2346x1568, 45° field of view: 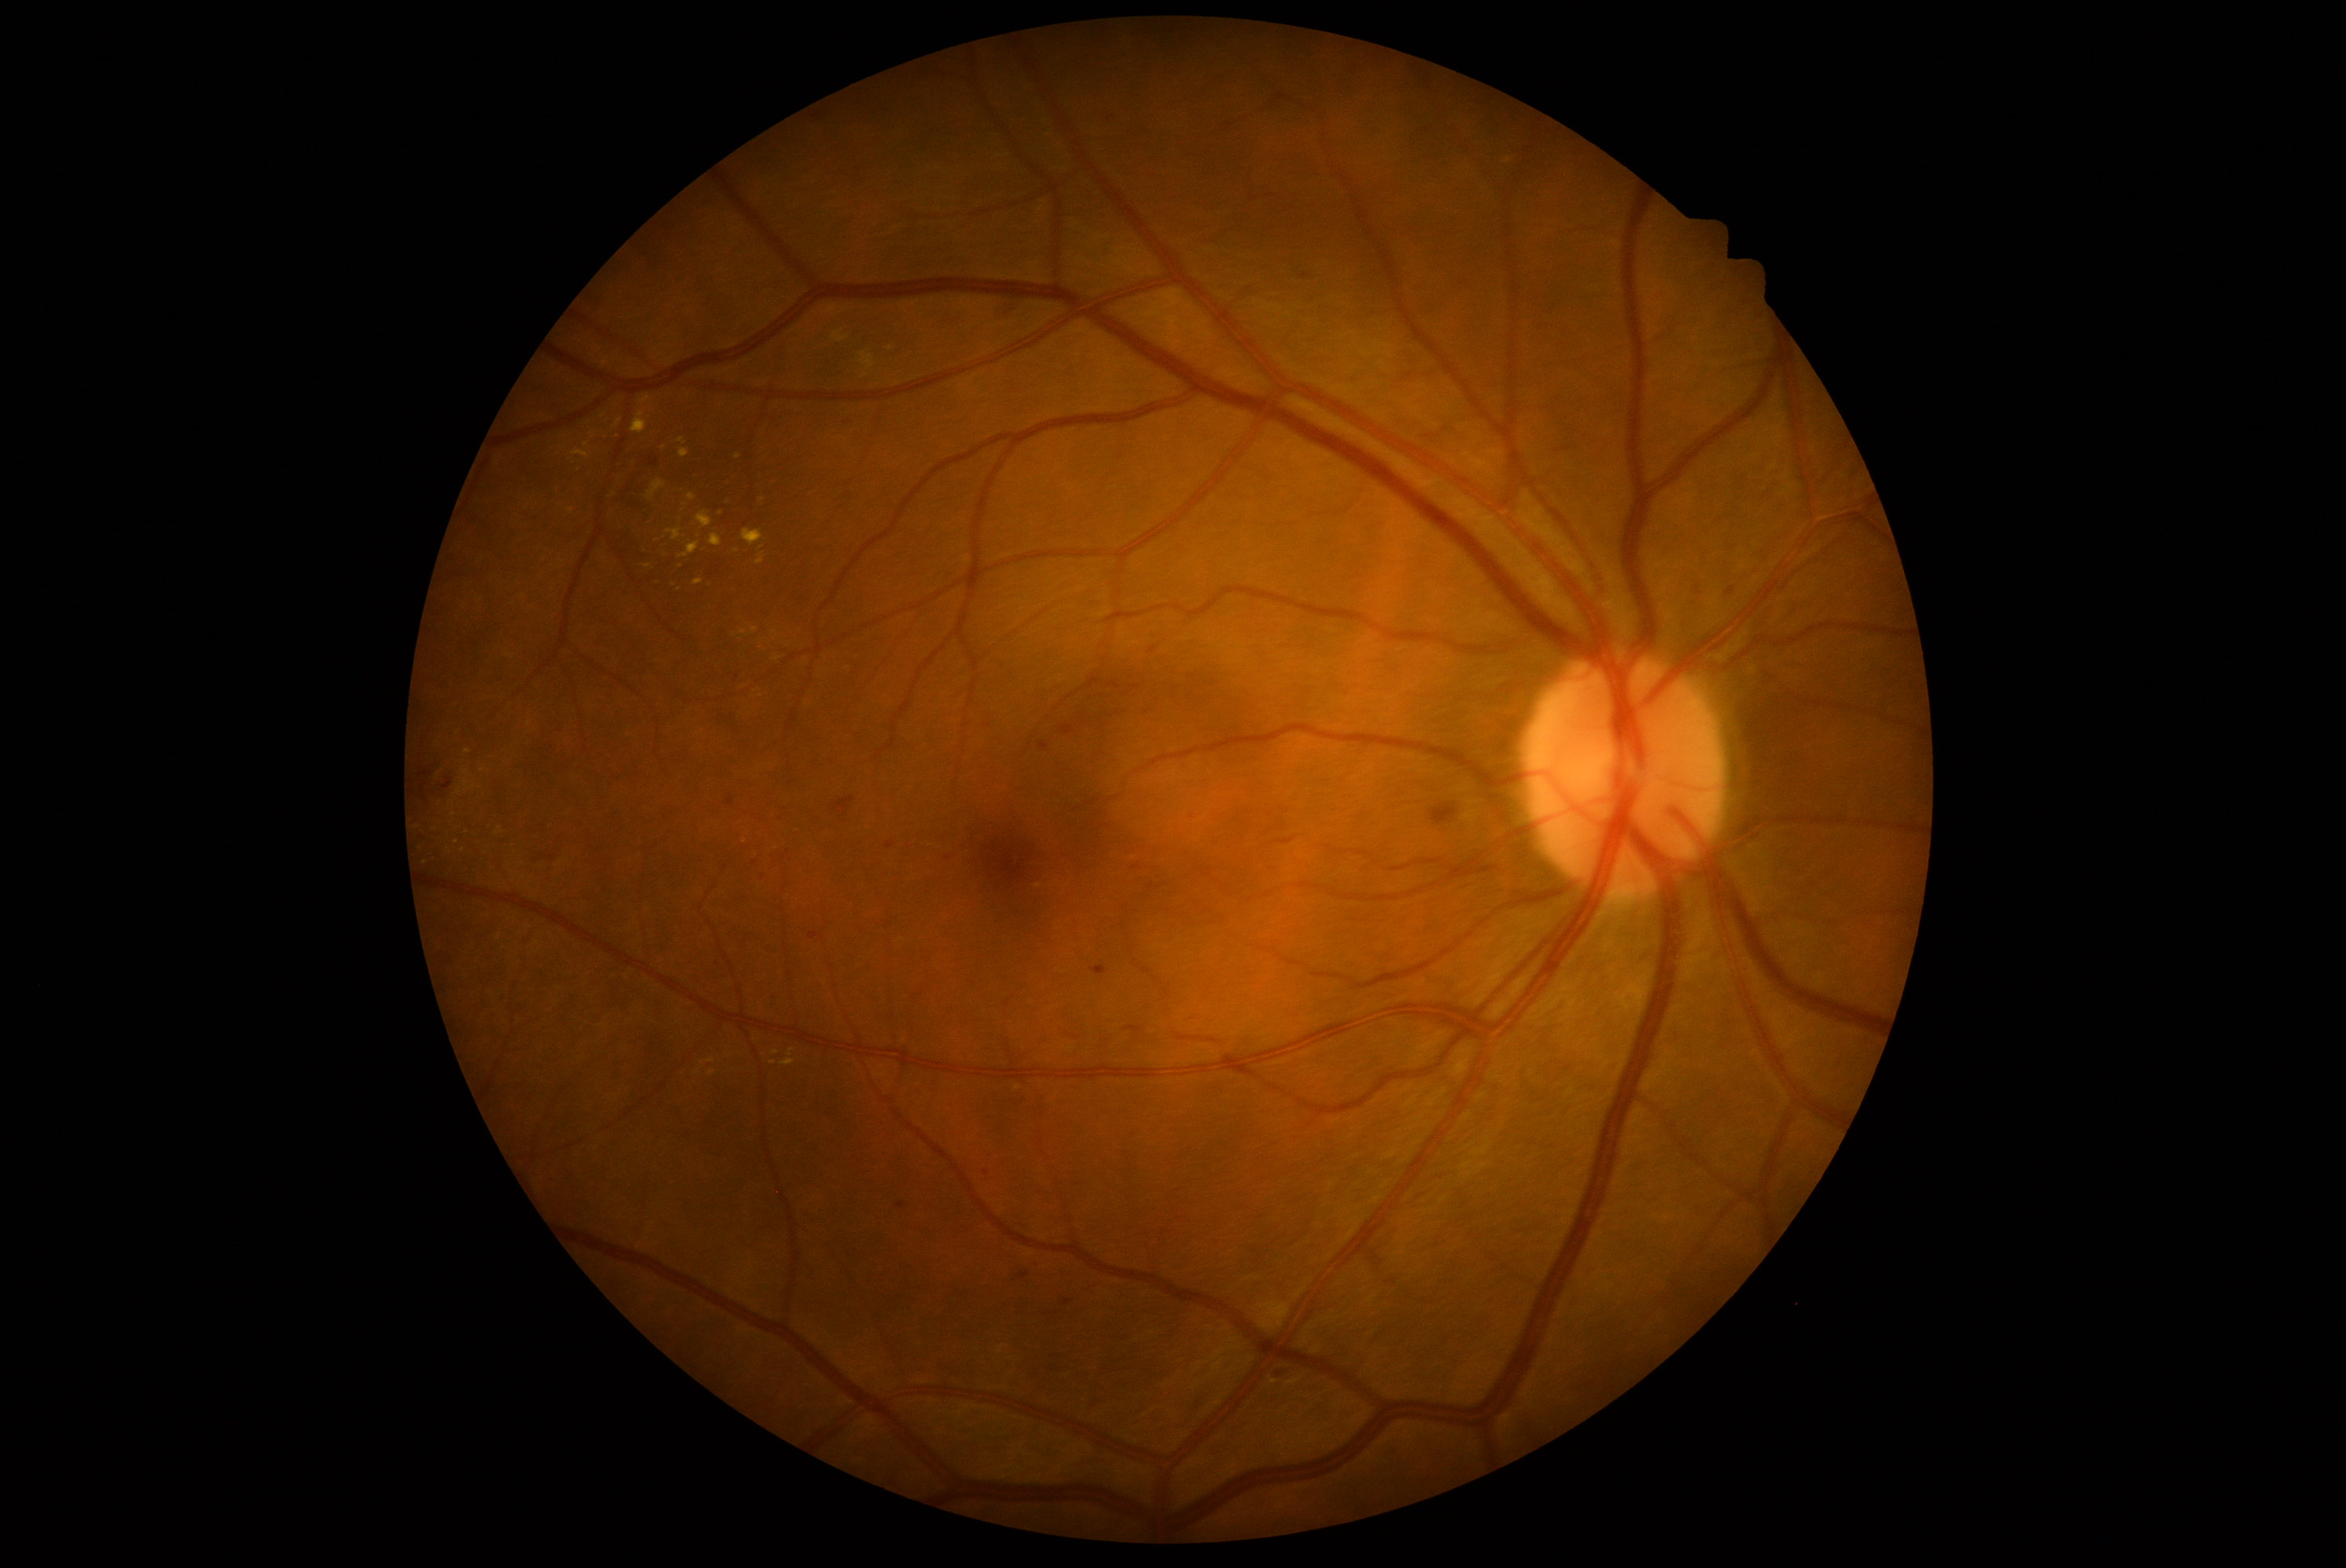 retinopathy grade: 2.